Acquired on the Phoenix ICON. Wide-field fundus photograph from neonatal ROP screening: 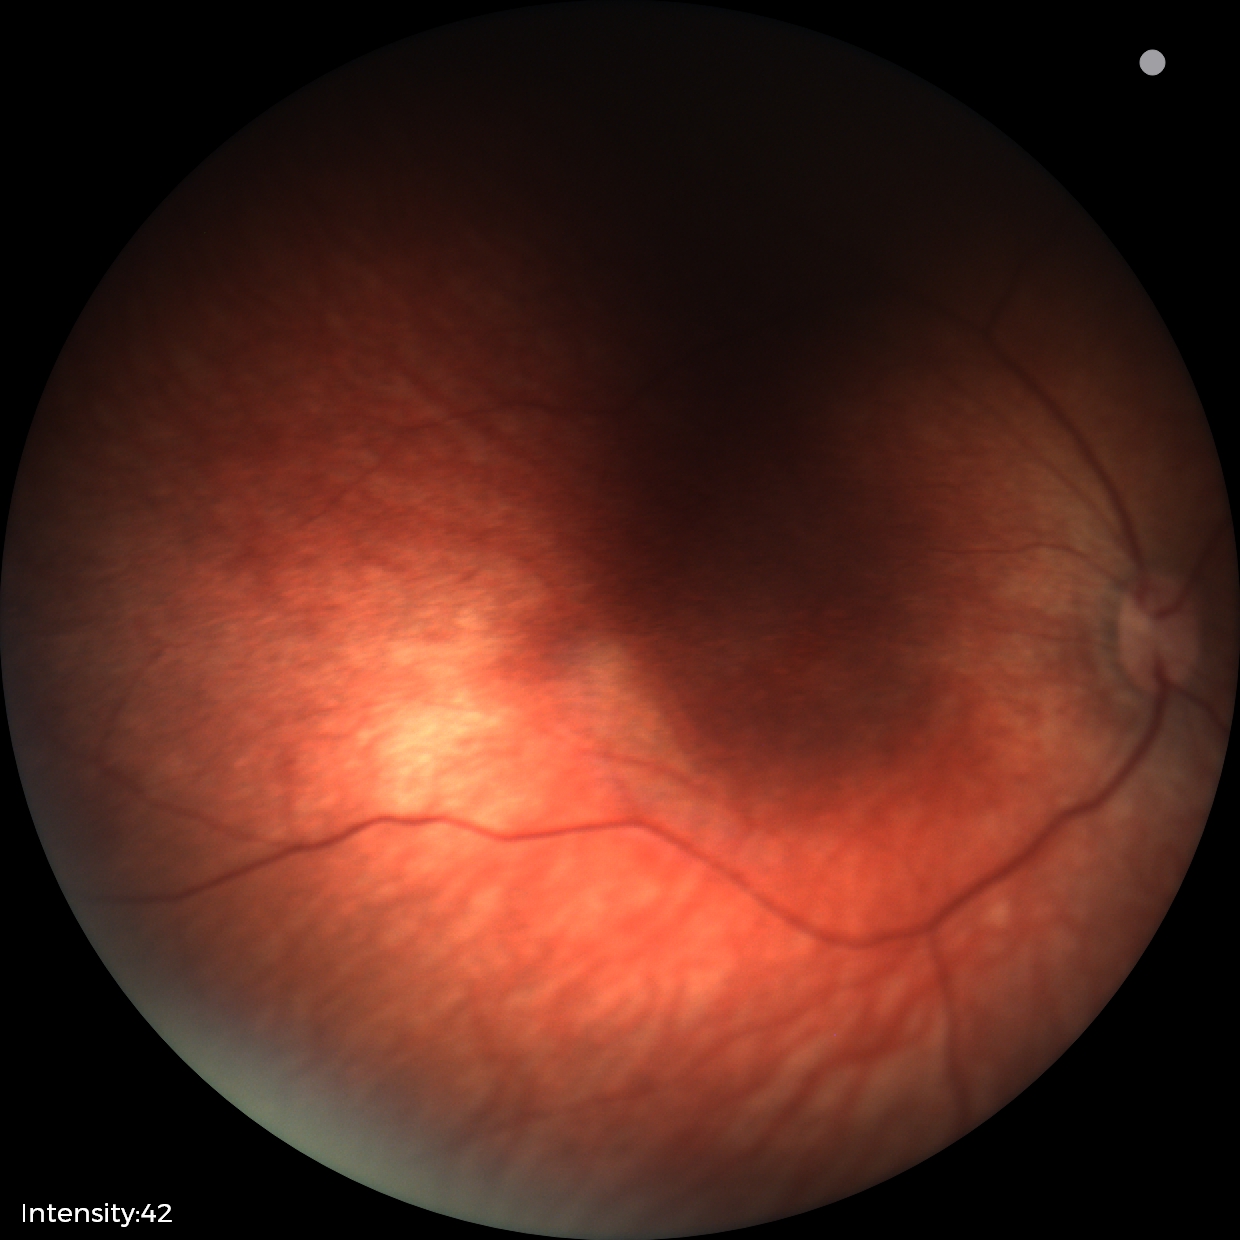

Q: What was the screening finding?
A: physiological finding